NIDEK AFC-230 fundus camera · nonmydriatic fundus photograph · 45° field of view · image size 848x848.
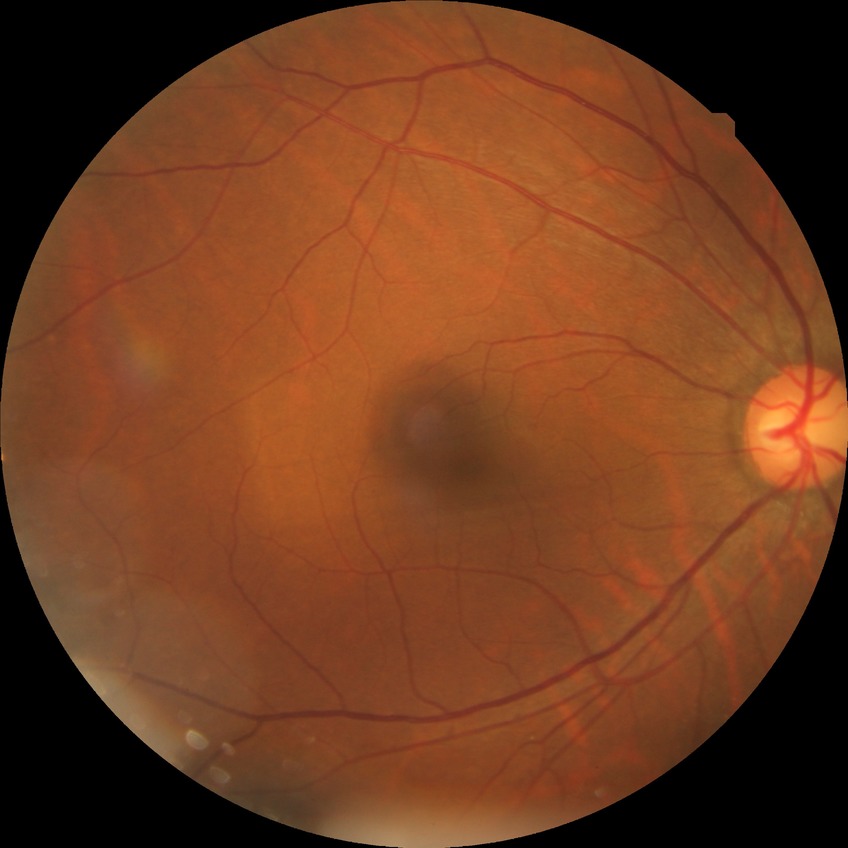
retinopathy grade@no diabetic retinopathy.